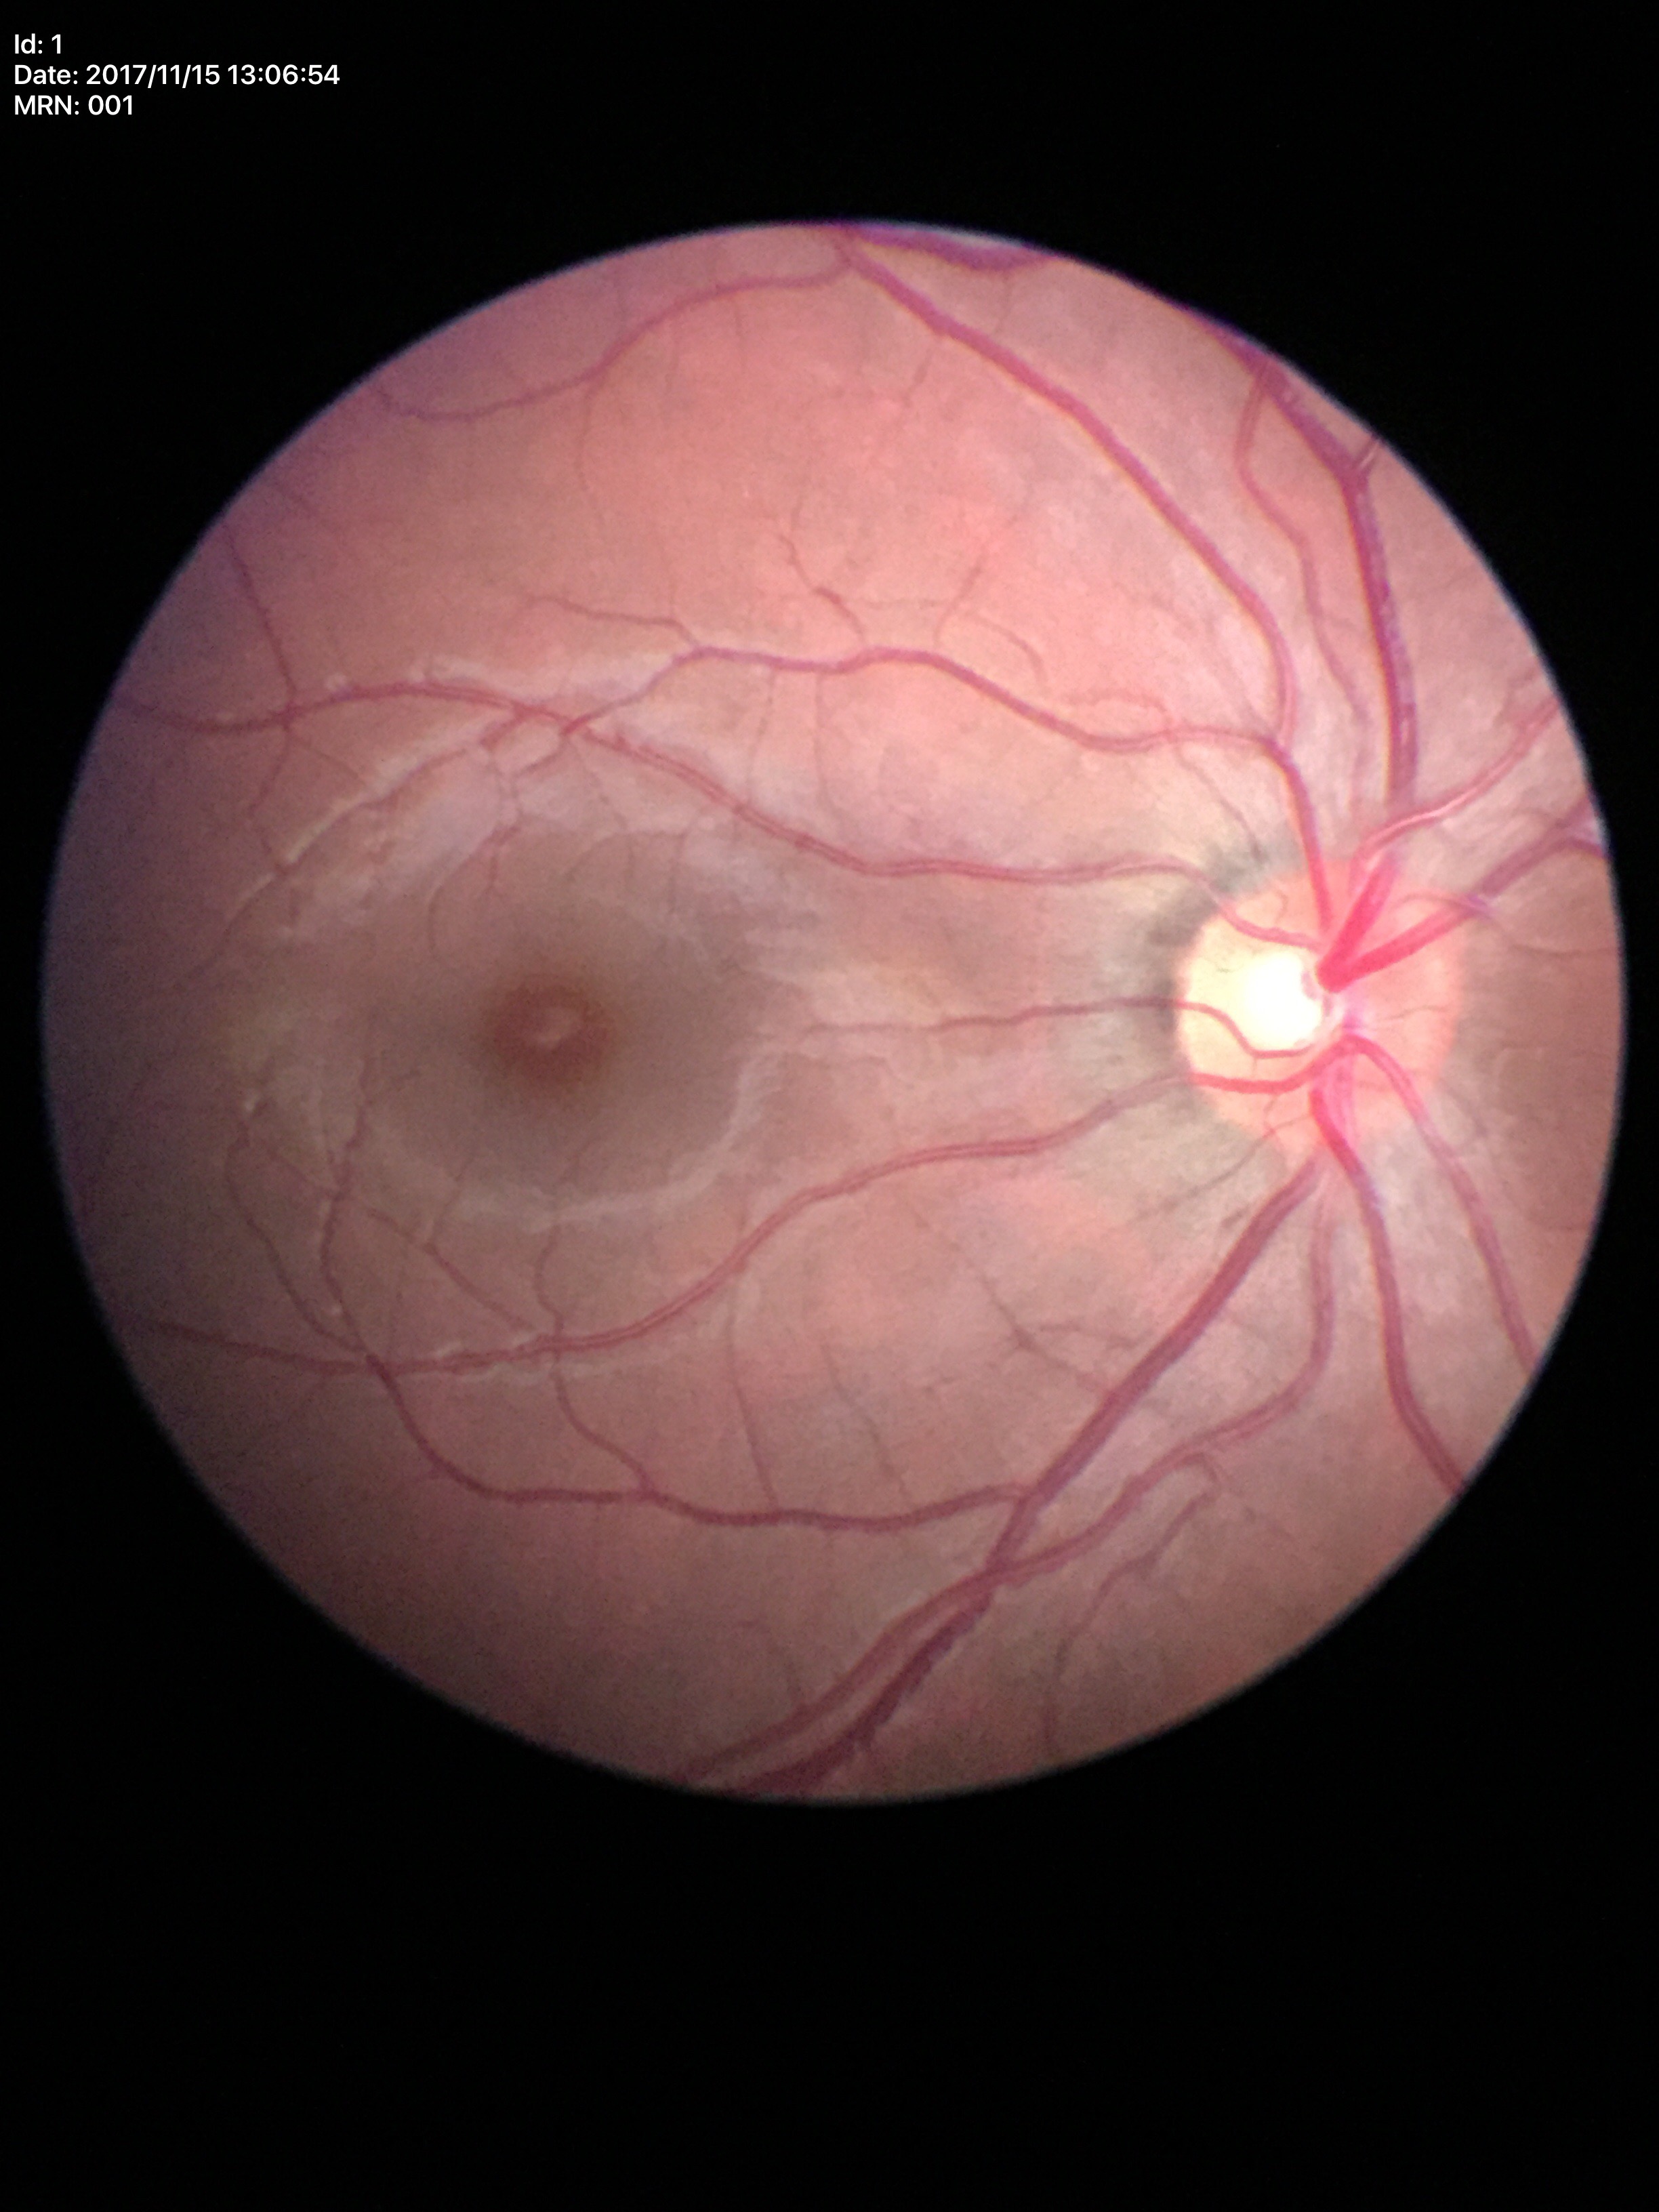

vertical C/D ratio: 0.48
Glaucoma screening impression: negative (5/5 ophthalmologists in agreement)
area C/D ratio: 0.28